100° field of view (Phoenix ICON) · infant wide-field retinal image:
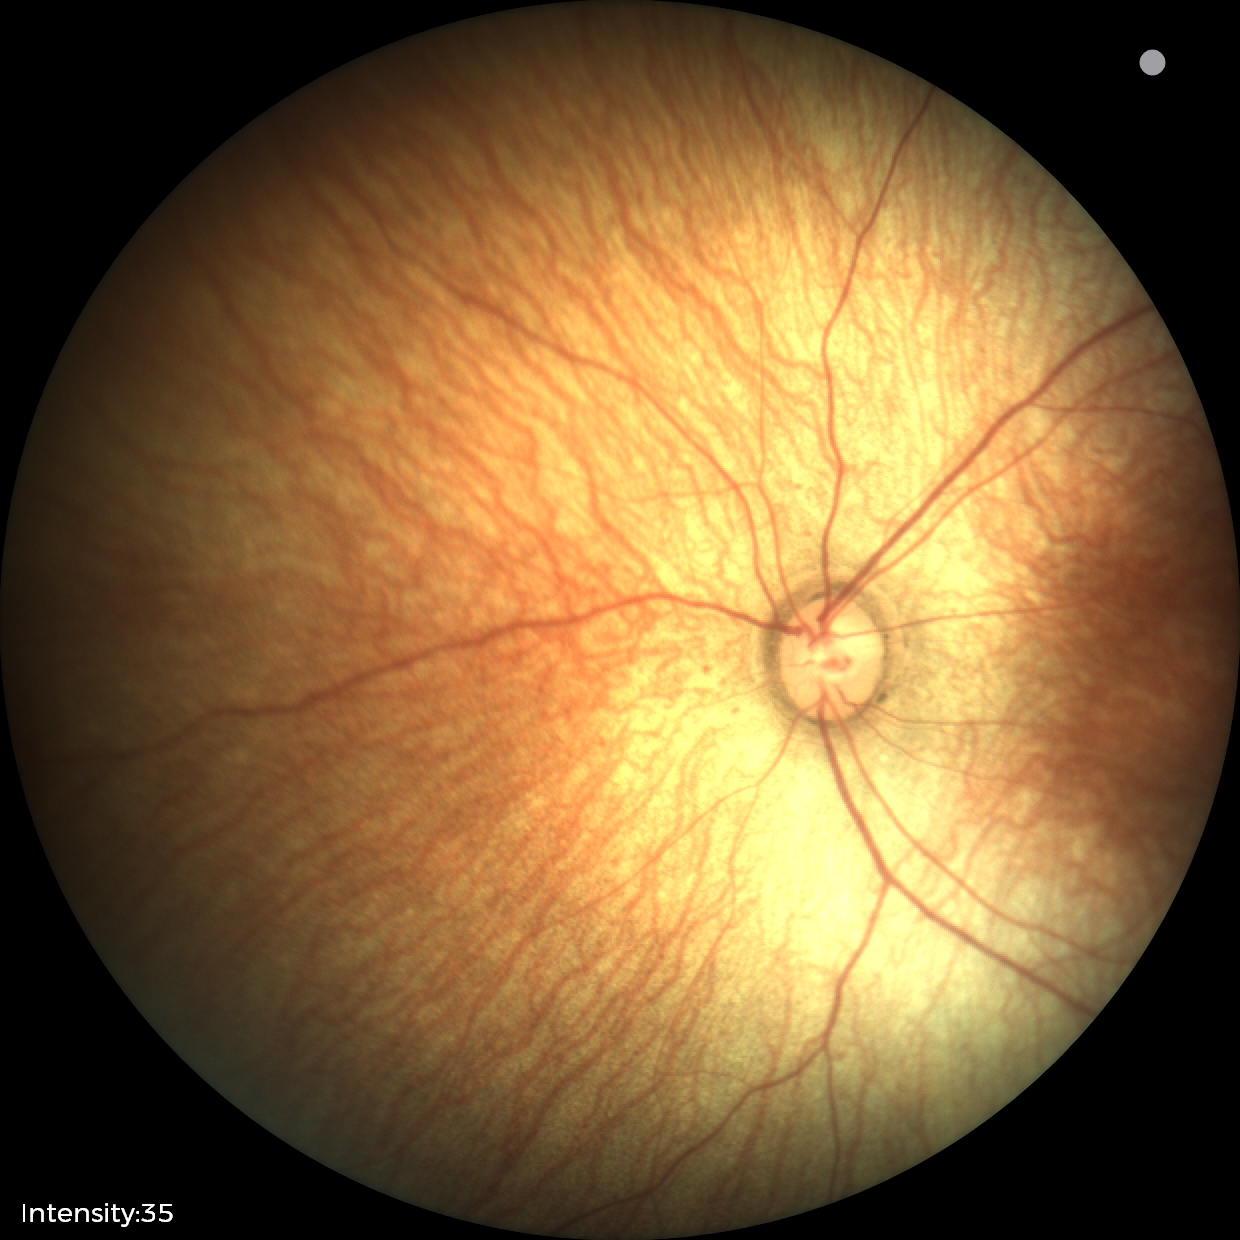

Screening diagnosis: no abnormalities